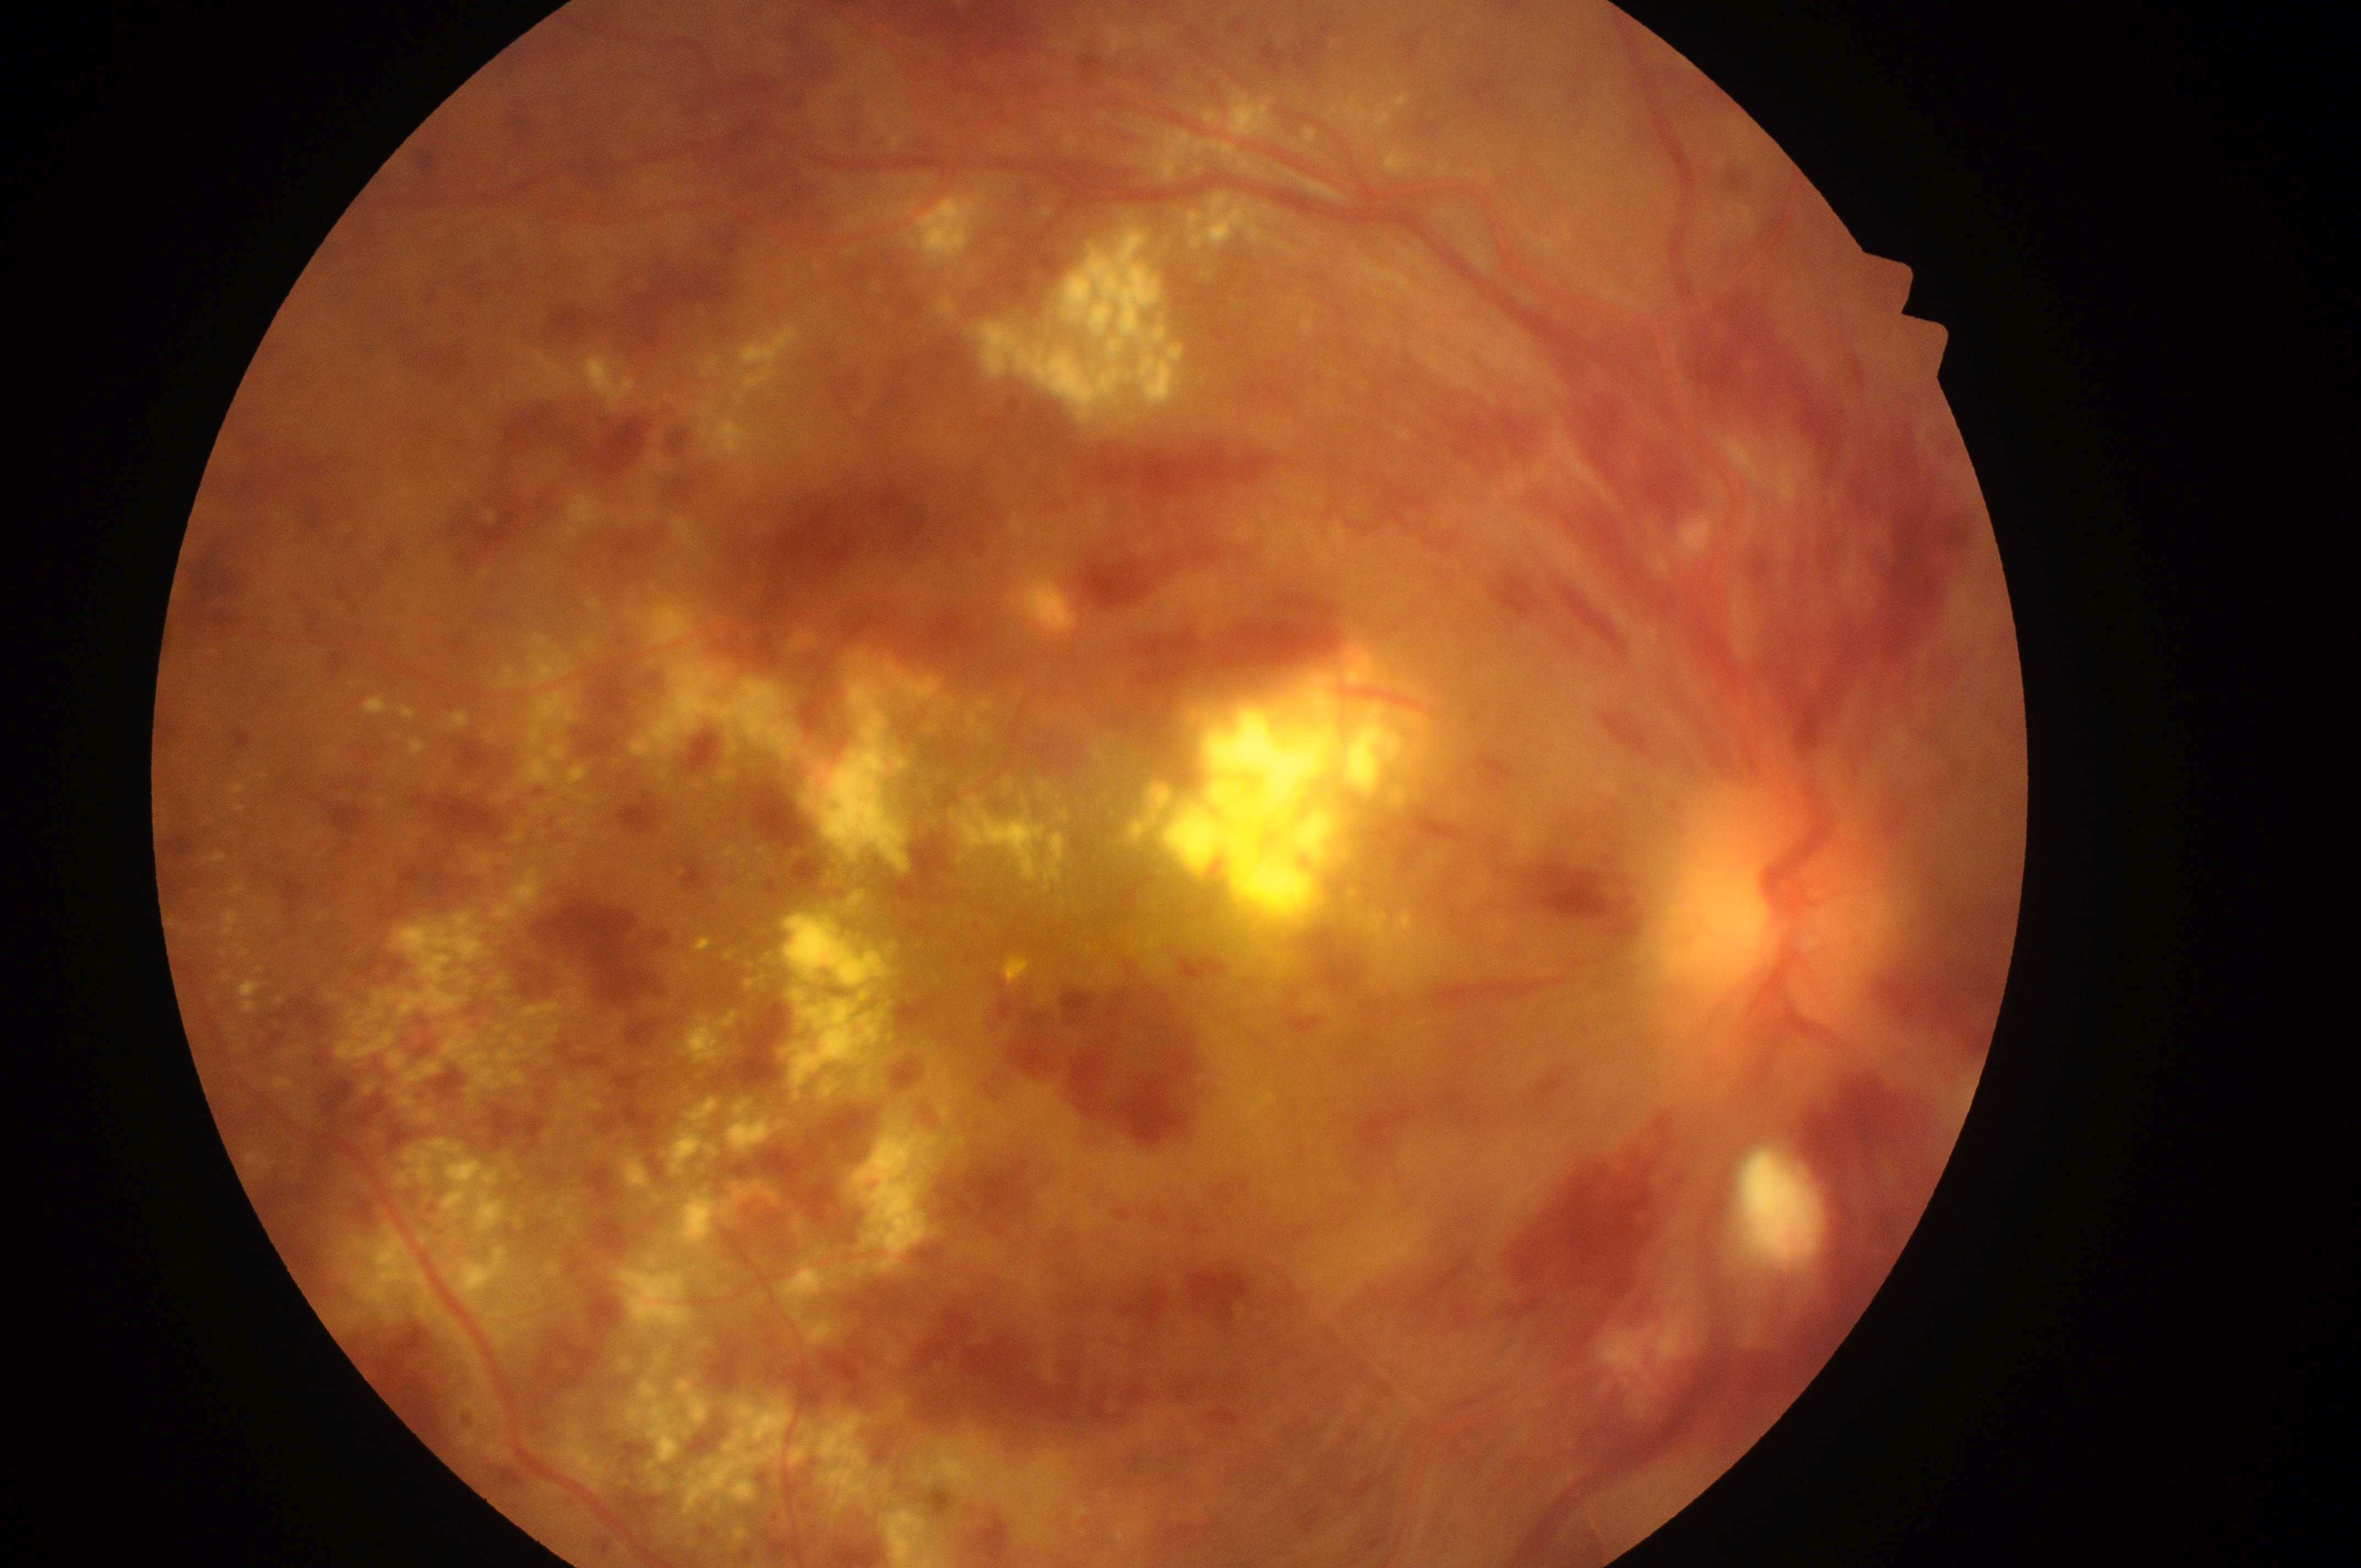

Diabetic retinopathy: grade 4 (PDR).
This is the right eye.
The optic disc center is at x=1786, y=932.
Diabetic macular edema: grade 2 (high risk).
The fovea is at x=998, y=886.